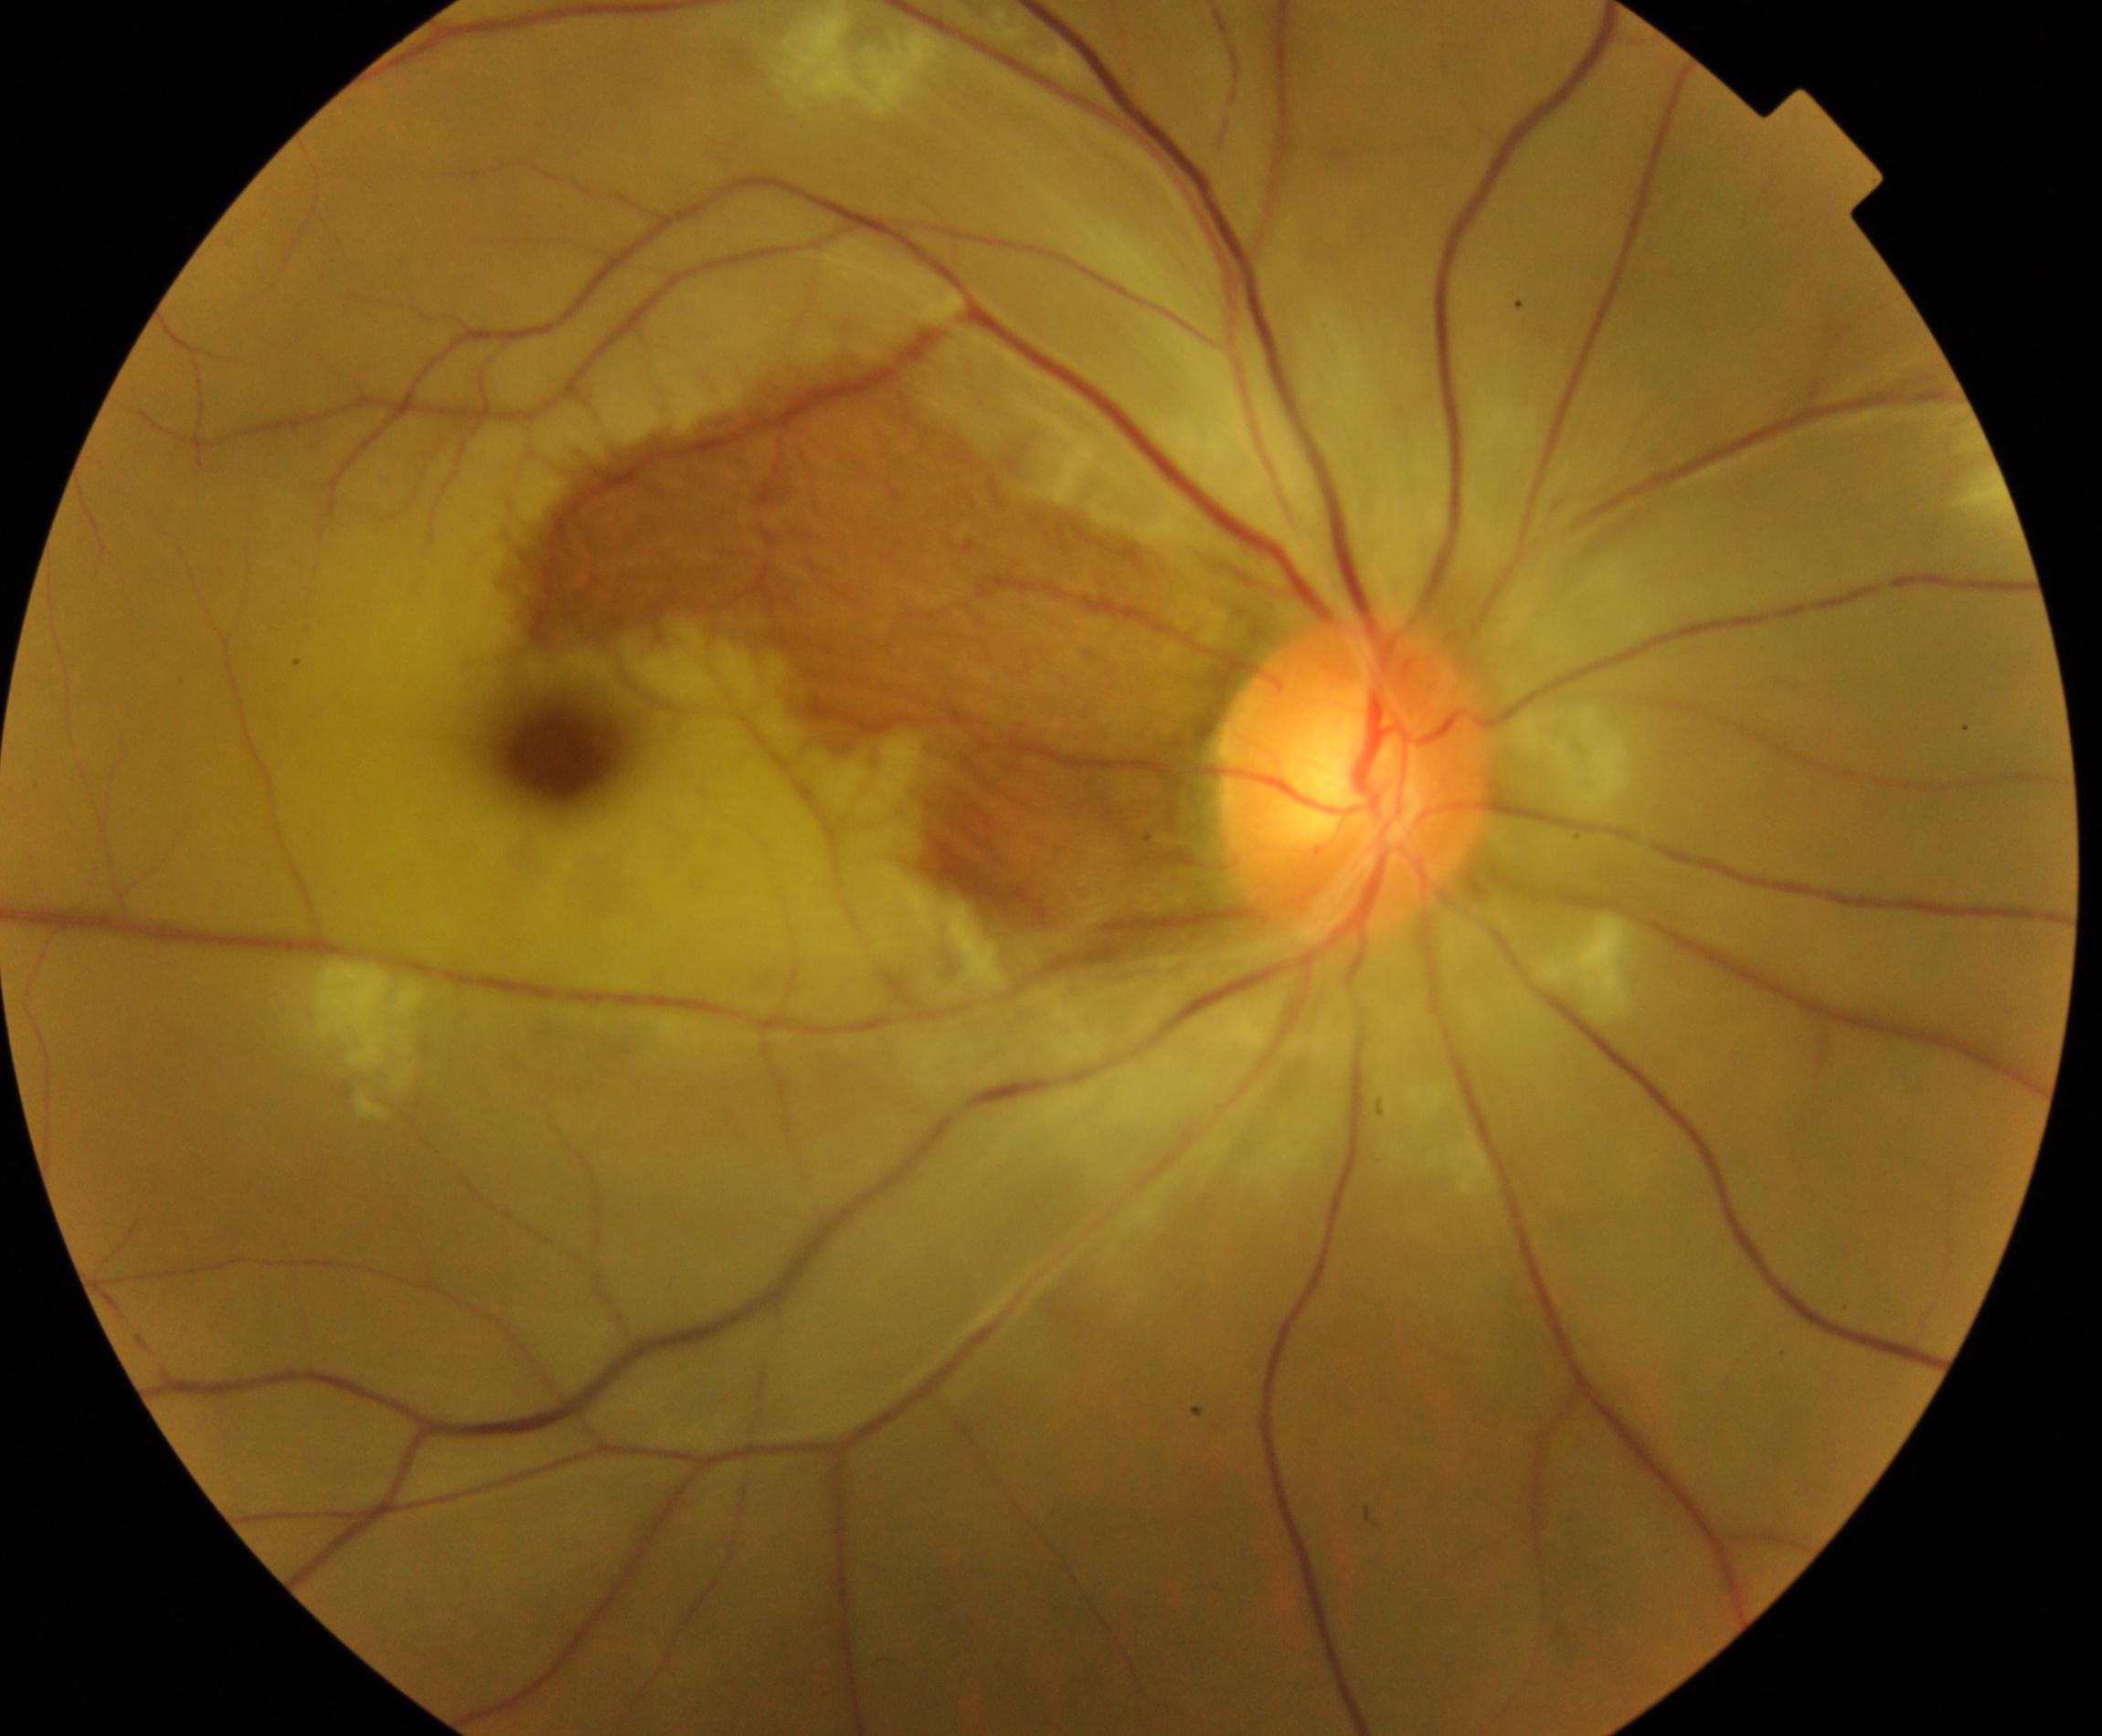

Color fundus photograph showing RAO (retinal artery occlusion).